1240x1240. Wide-field fundus photograph of an infant
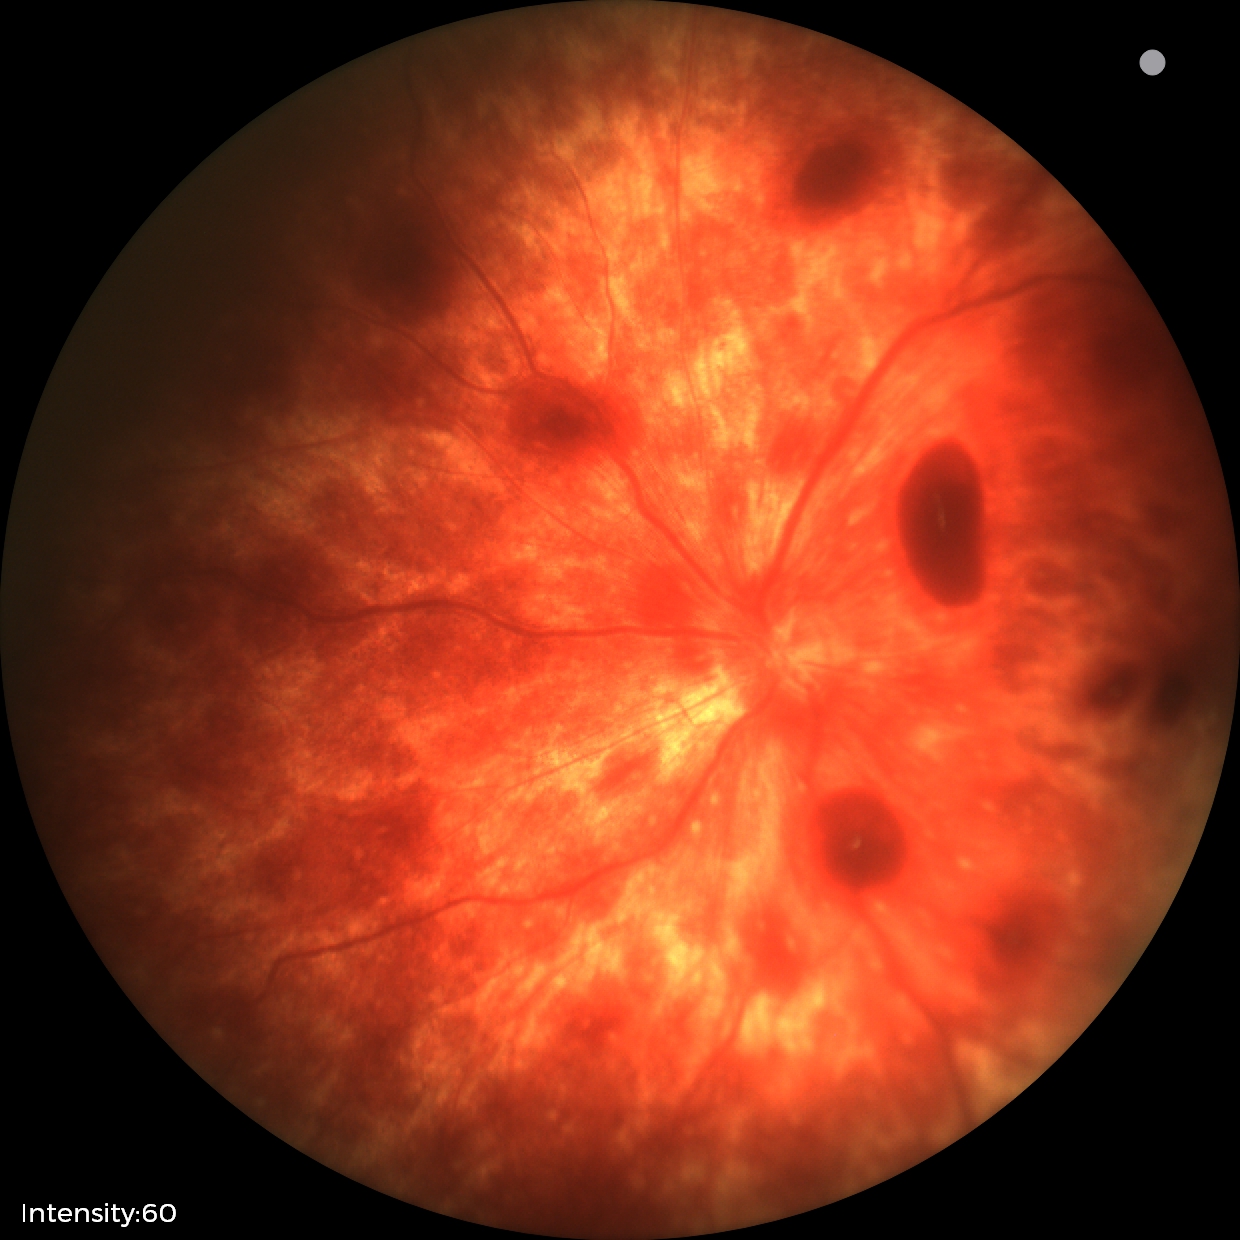
Assessment: retinal hemorrhages.